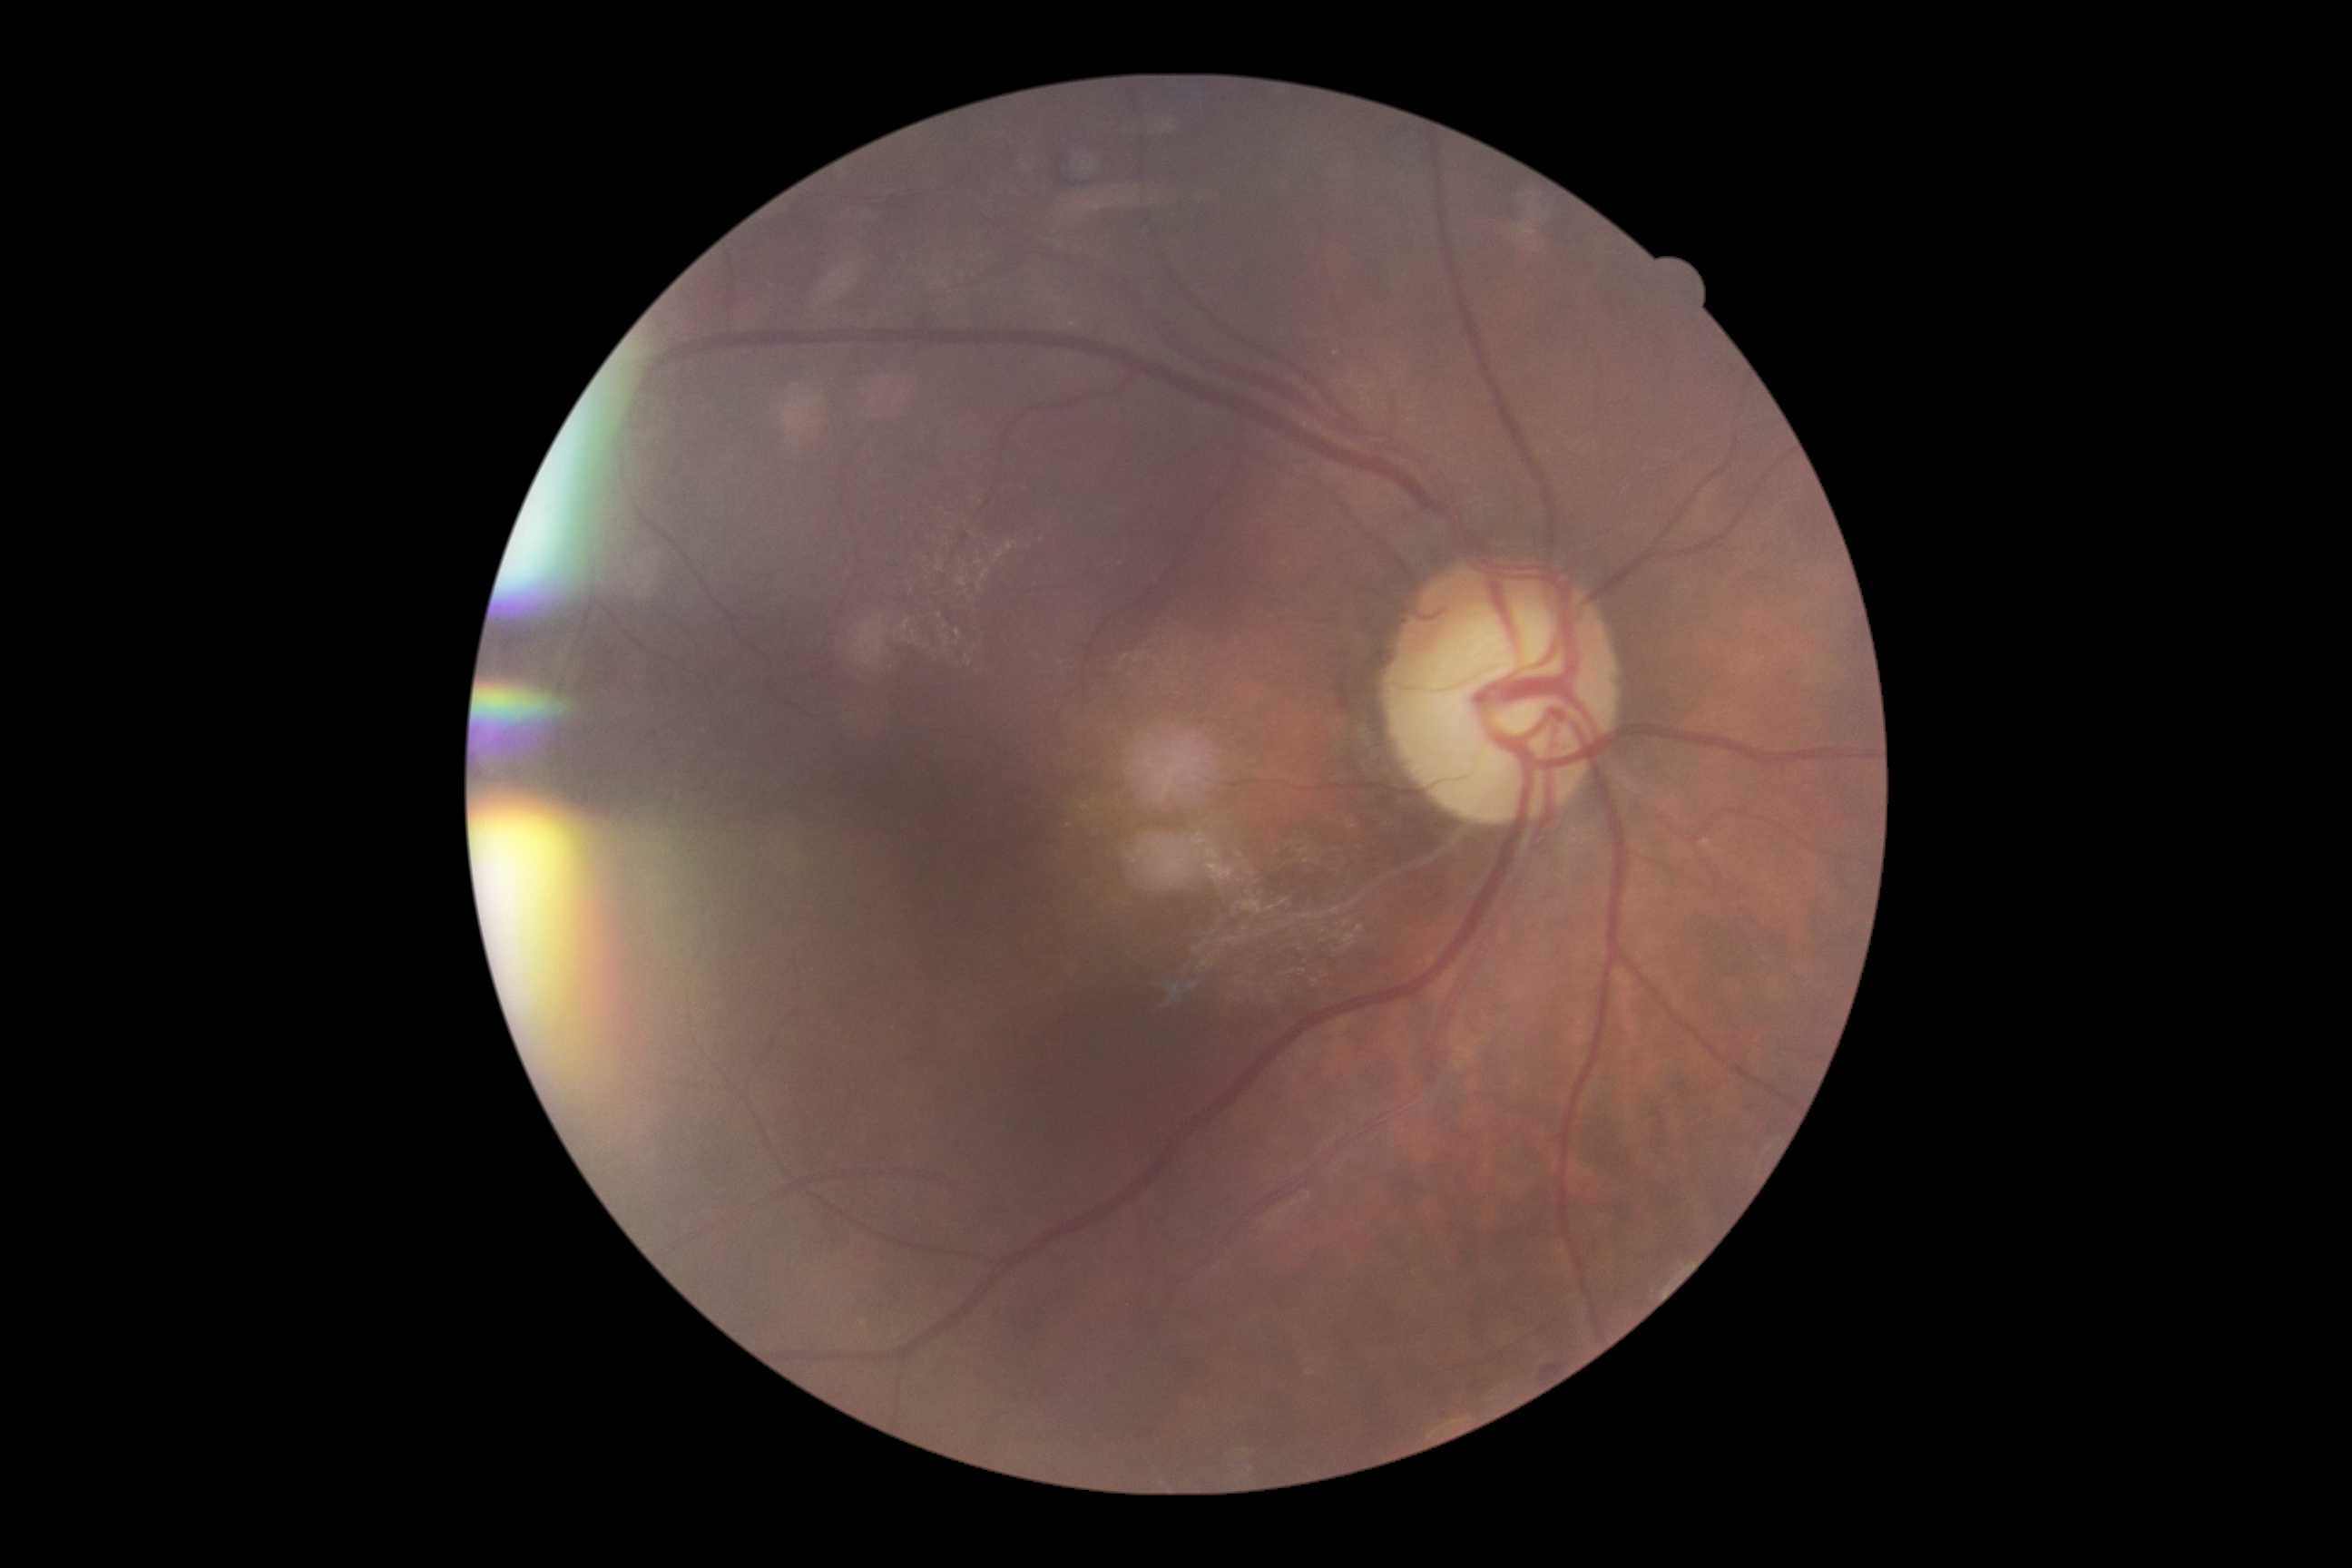 Findings:
– diabetic retinopathy (DR): moderate non-proliferative diabetic retinopathy (grade 2)
– DR class: non-proliferative diabetic retinopathy